Camera: Phoenix ICON (100° FOV). Wide-field contact fundus photograph of an infant — 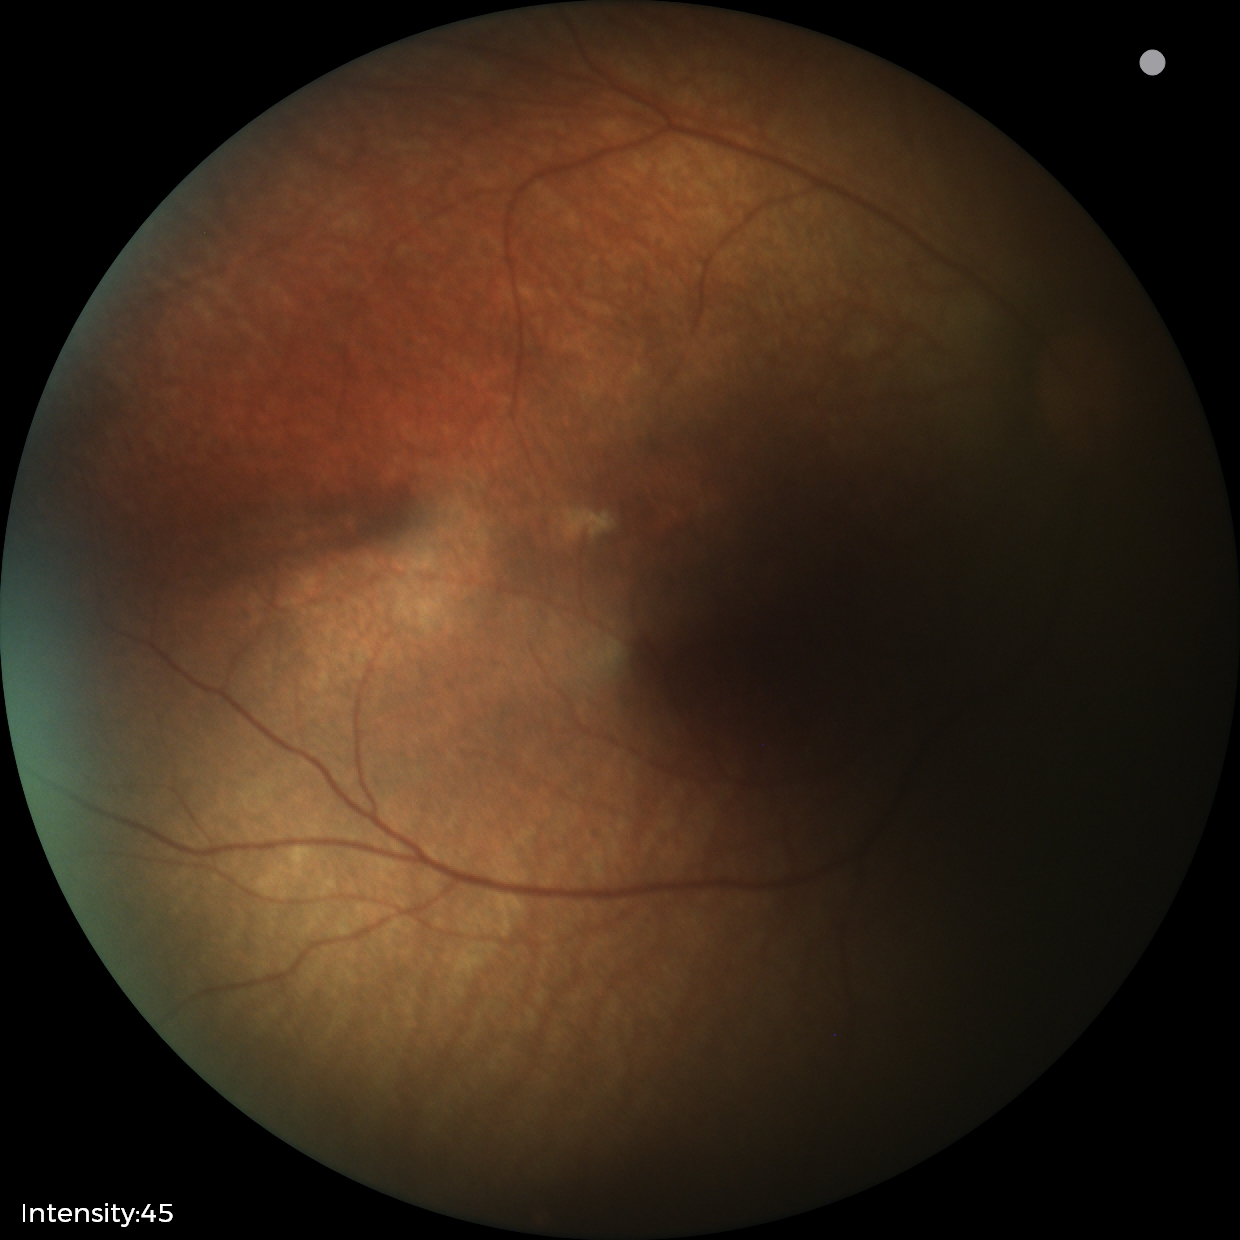
No retinal pathology identified on screening.